2352 x 1568 pixels. 45-degree field of view:
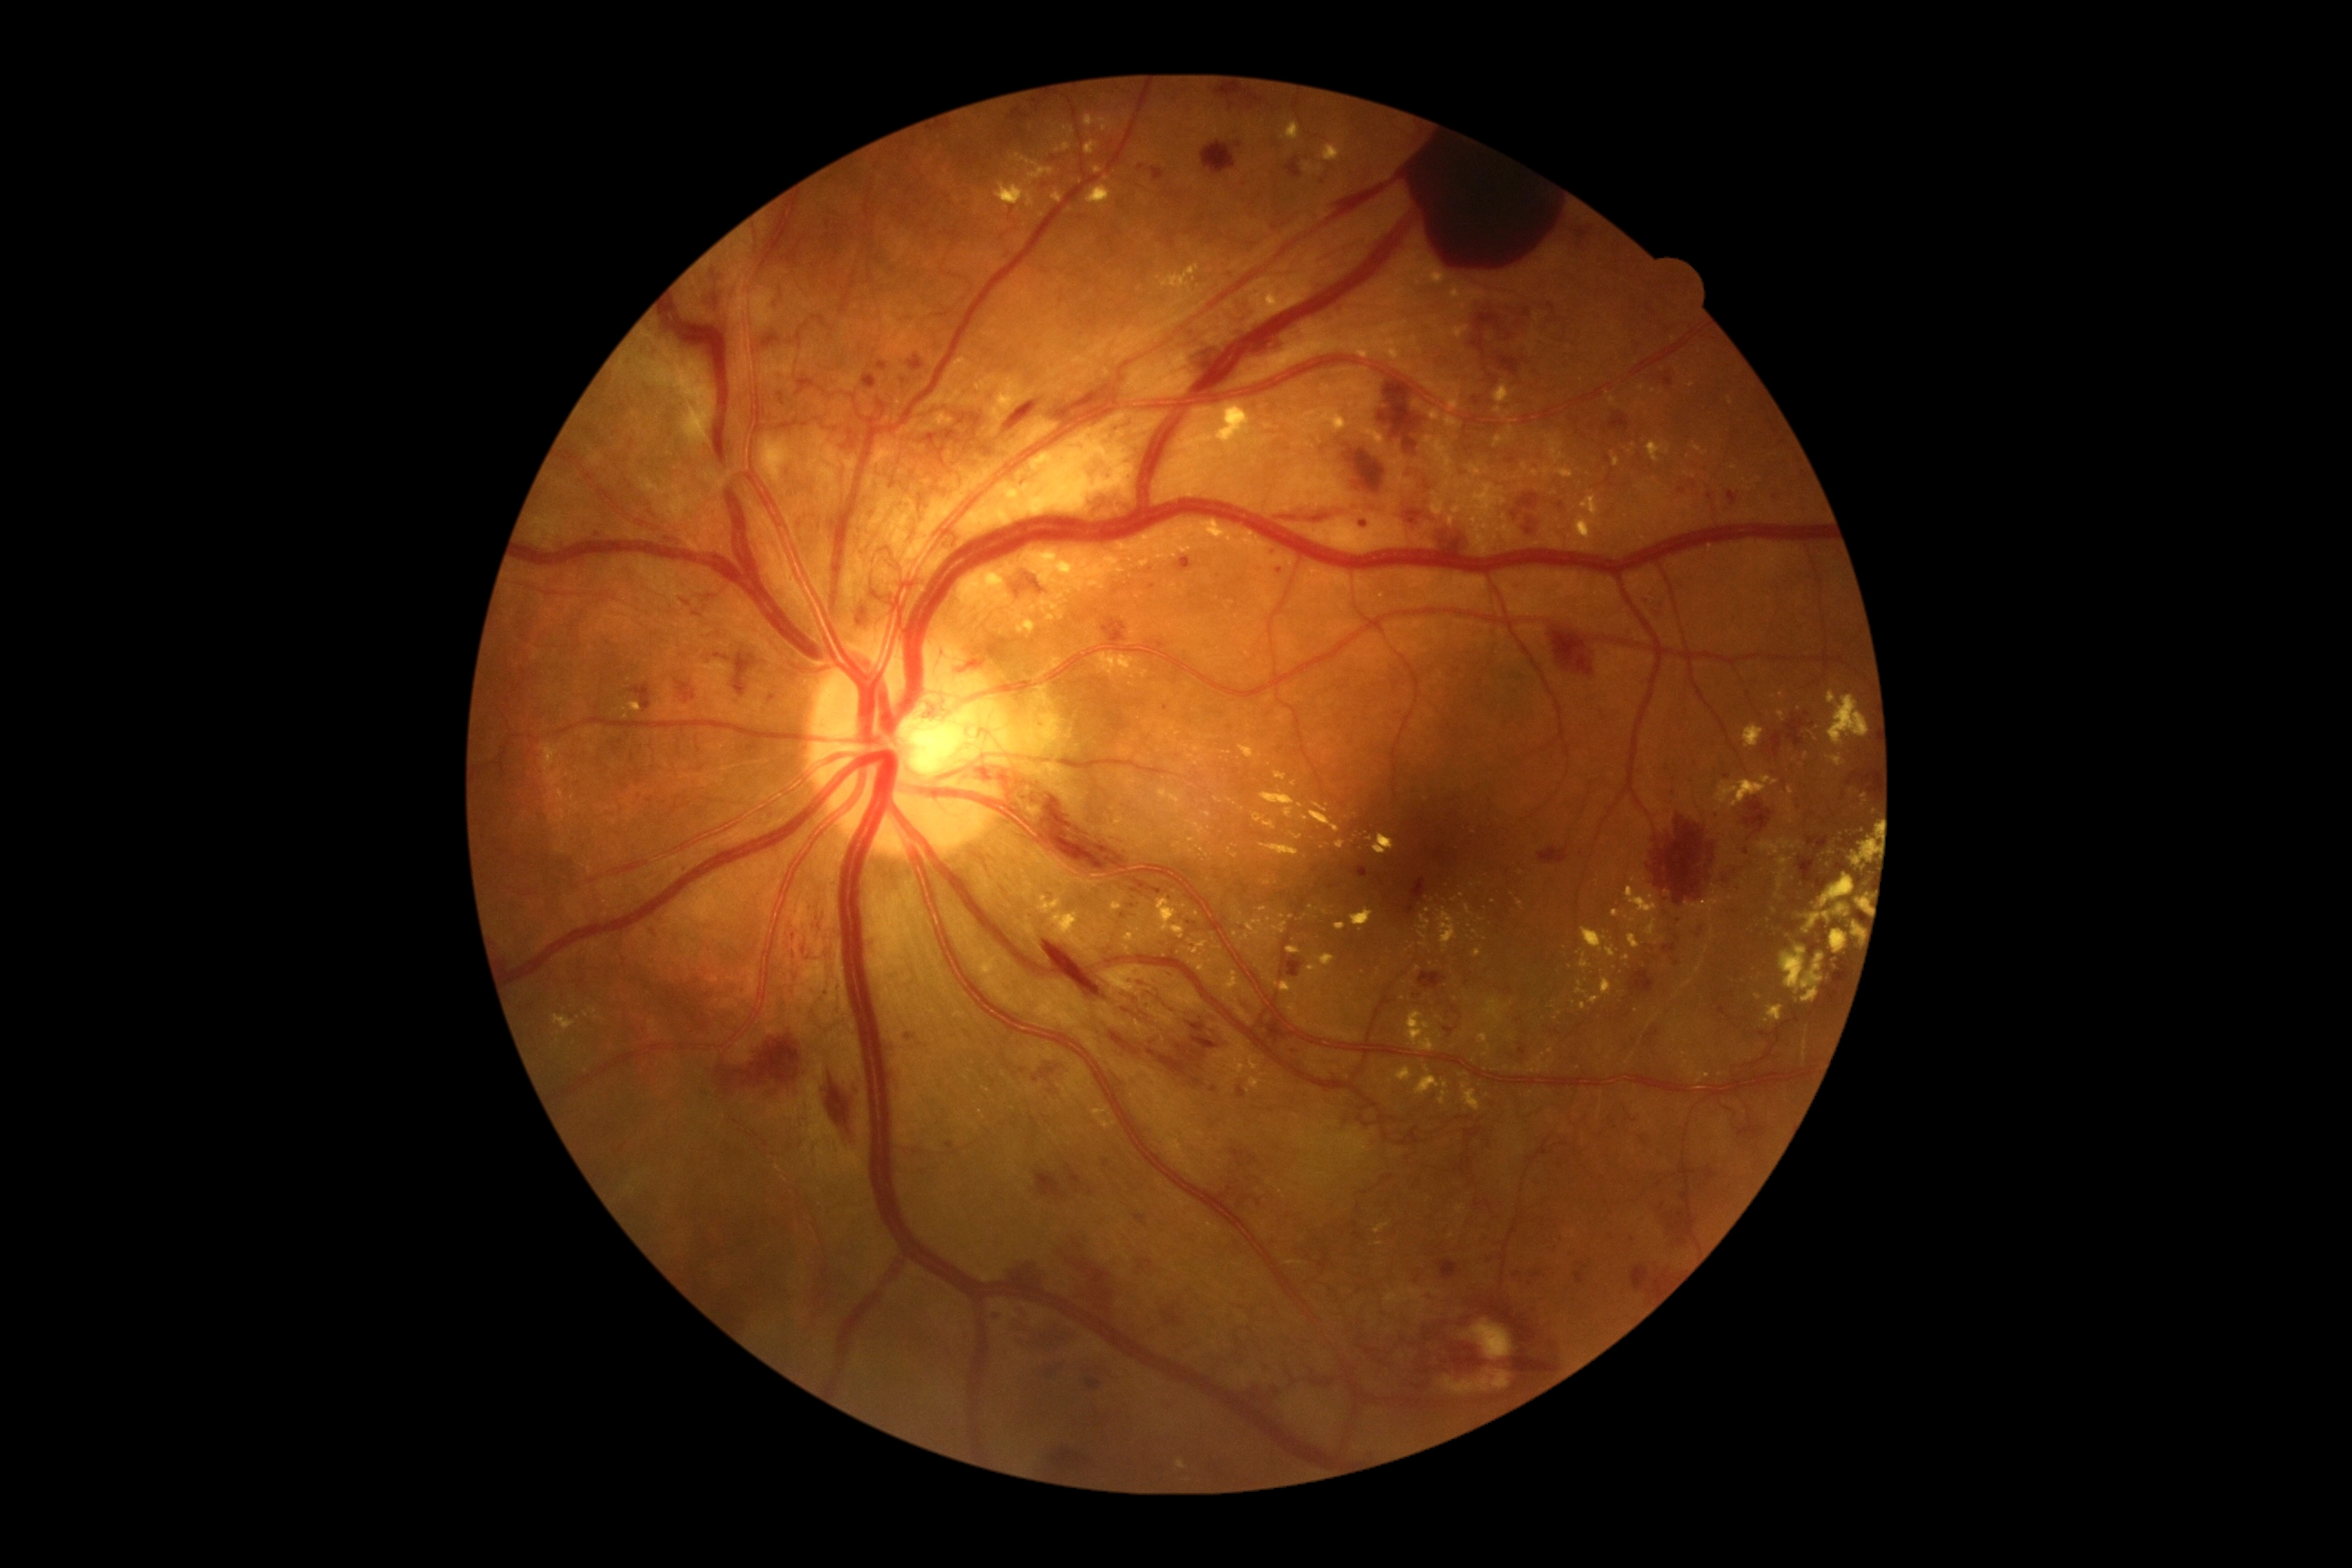 Diabetic retinopathy (DR): proliferative diabetic retinopathy (grade 4)
Lesions identified (partial list):
hard exudates (EXs) (subset): [1159,730,1170,741]; [1716,776,1778,810]; [1774,856,1792,899]; [1217,406,1251,446]; [1453,326,1469,340]; [1623,956,1631,961]; [1852,923,1859,937]; [1335,923,1346,930]; [1494,427,1514,447]; [1375,1222,1391,1233]; [1260,845,1300,858]
Smaller EXs around 1482/920; 1583/1006; 1098/170; 1445/1084; 1294/784; 1271/944; 1489/1048